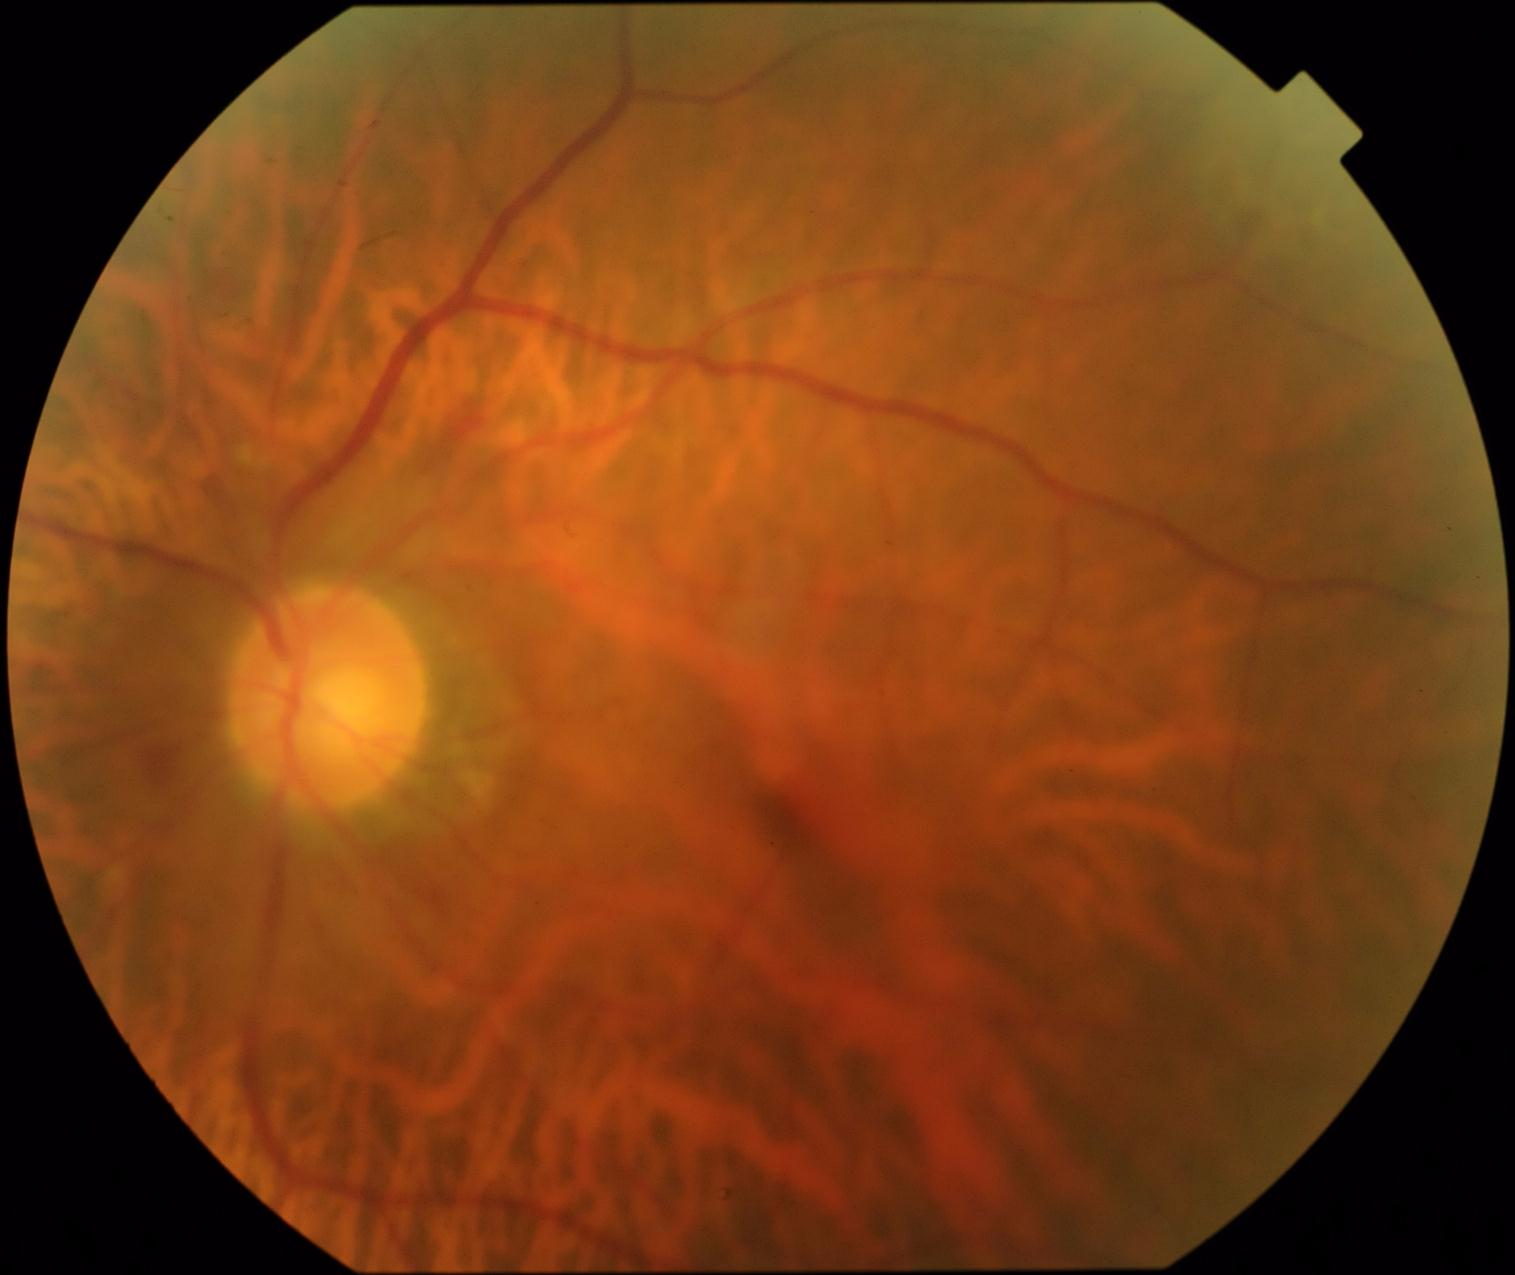
  dr_grade: grade 2